Wide-field fundus photograph from neonatal ROP screening · 130° field of view (Clarity RetCam 3) · 640 by 480 pixels
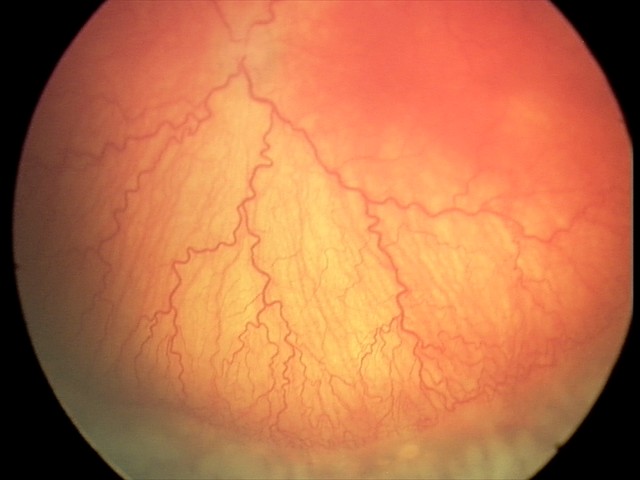
Examination diagnosed as A-ROP (aggressive ROP).
Plus disease present.